45 degree fundus photograph, NIDEK AFC-230, nonmydriatic fundus photograph, image size 848x848, color fundus image: 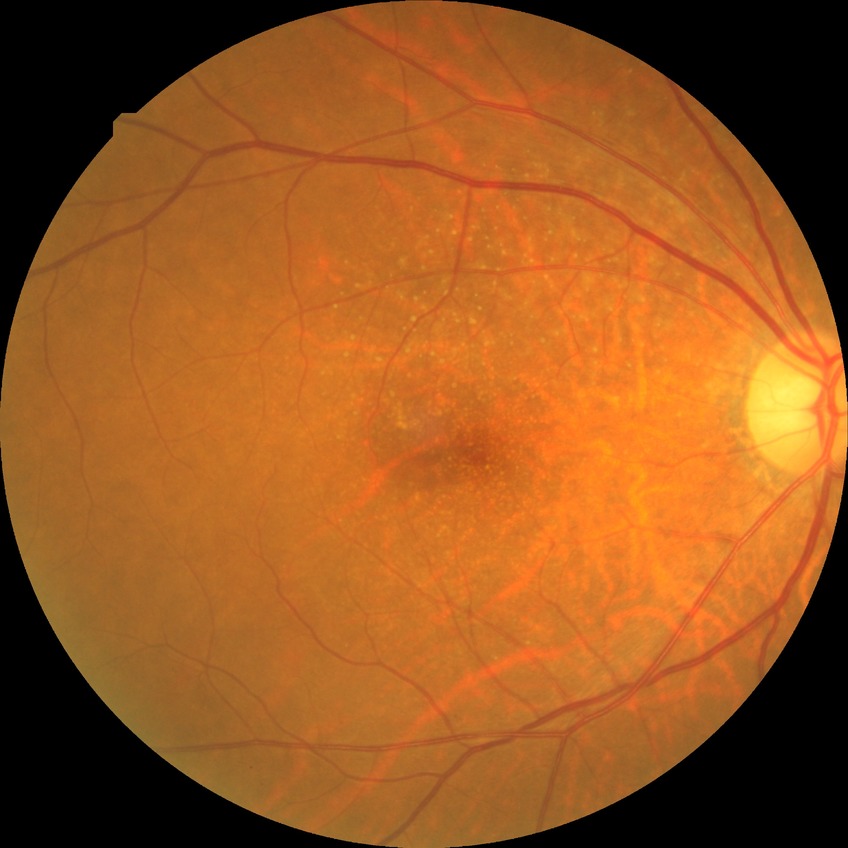
diabetic retinopathy stage = simple diabetic retinopathy.